Without pupil dilation
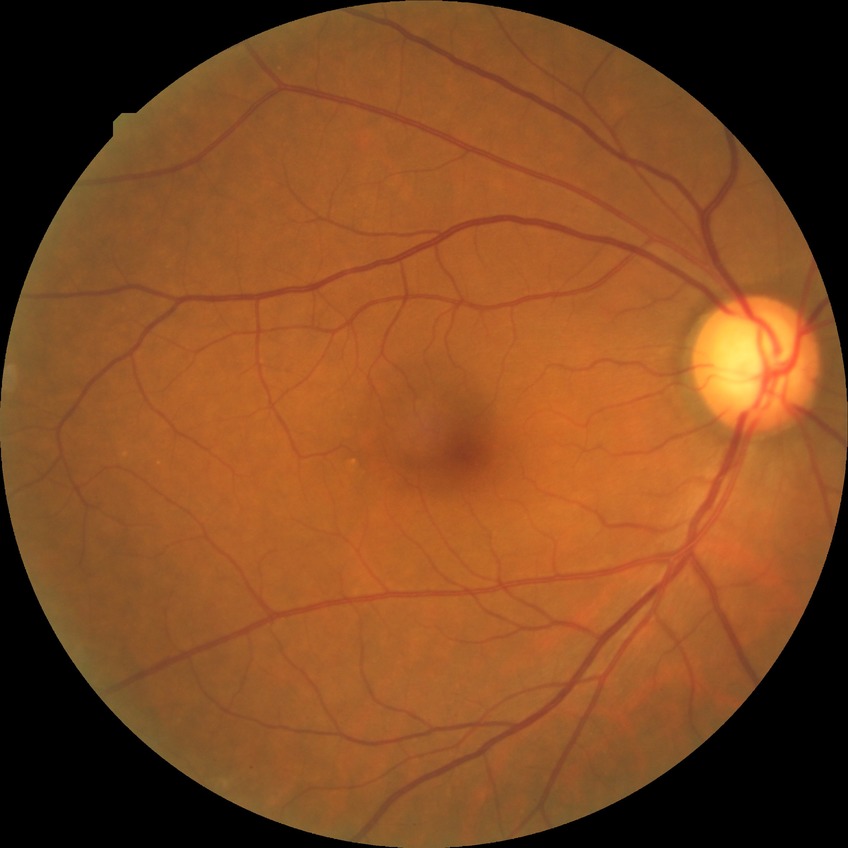 Diabetic retinopathy severity is no diabetic retinopathy.